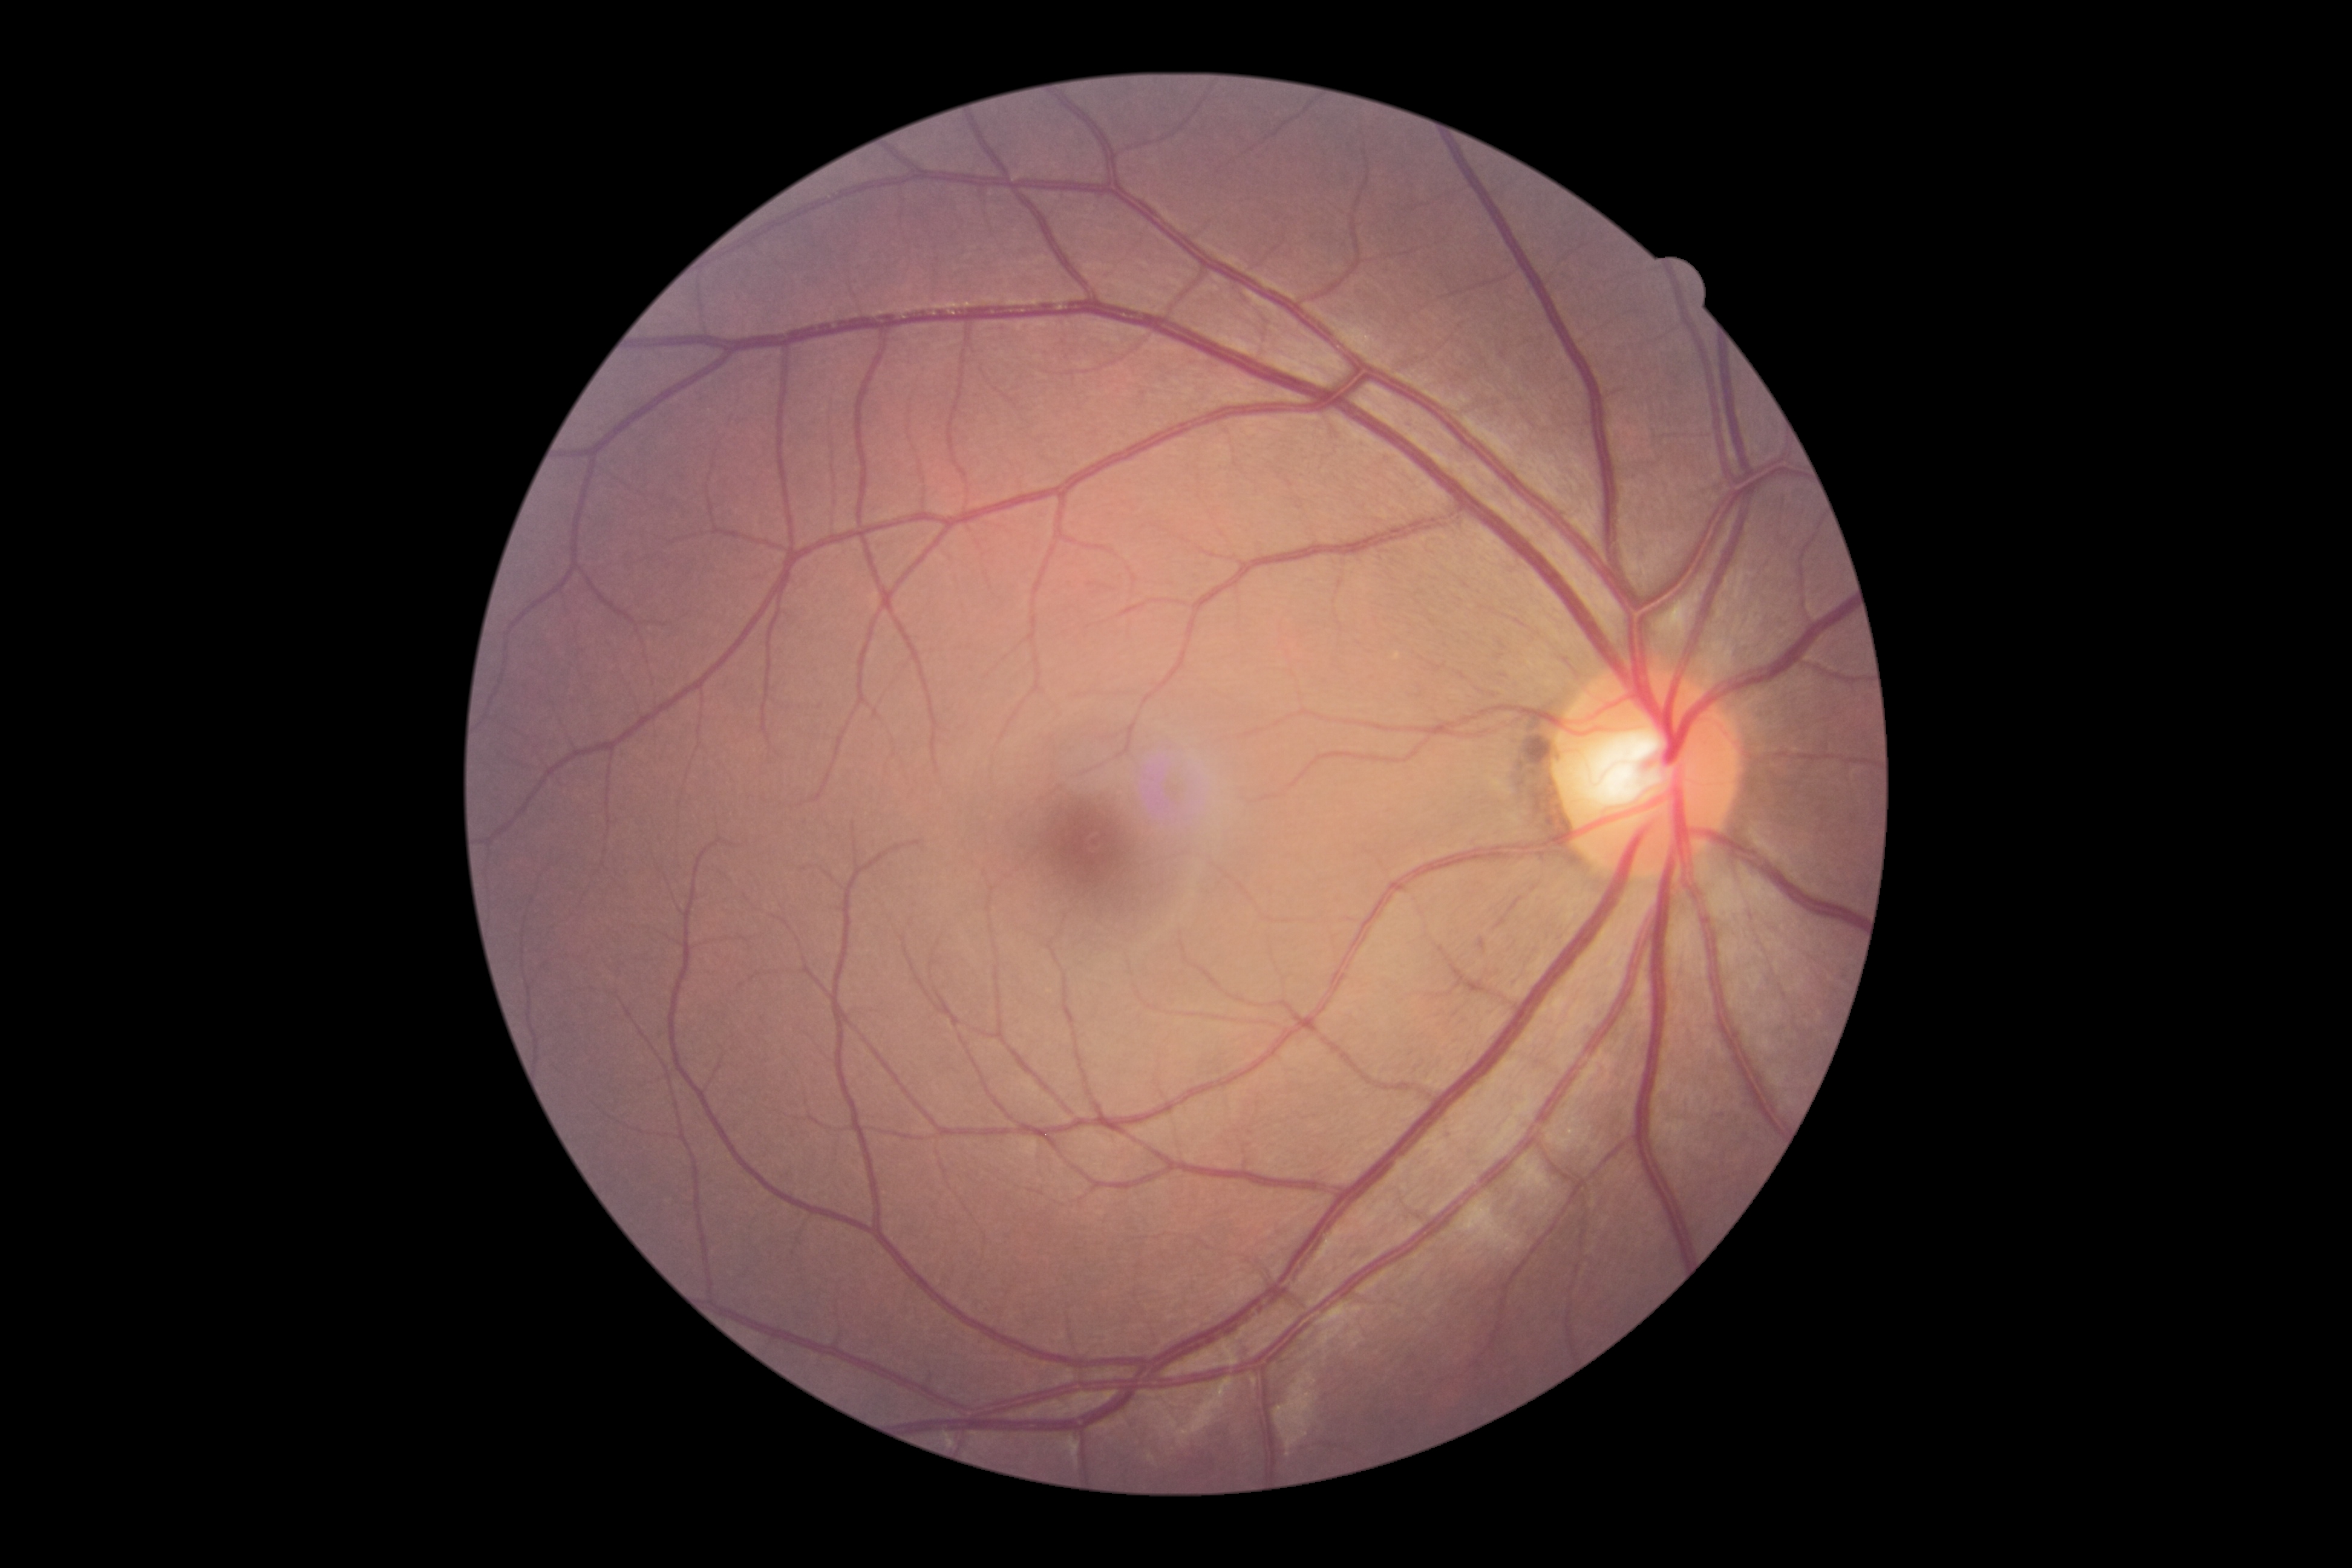

DR stage = grade 0 (no apparent retinopathy), DR impression = no signs of DR.